Pediatric retinal photograph (wide-field):
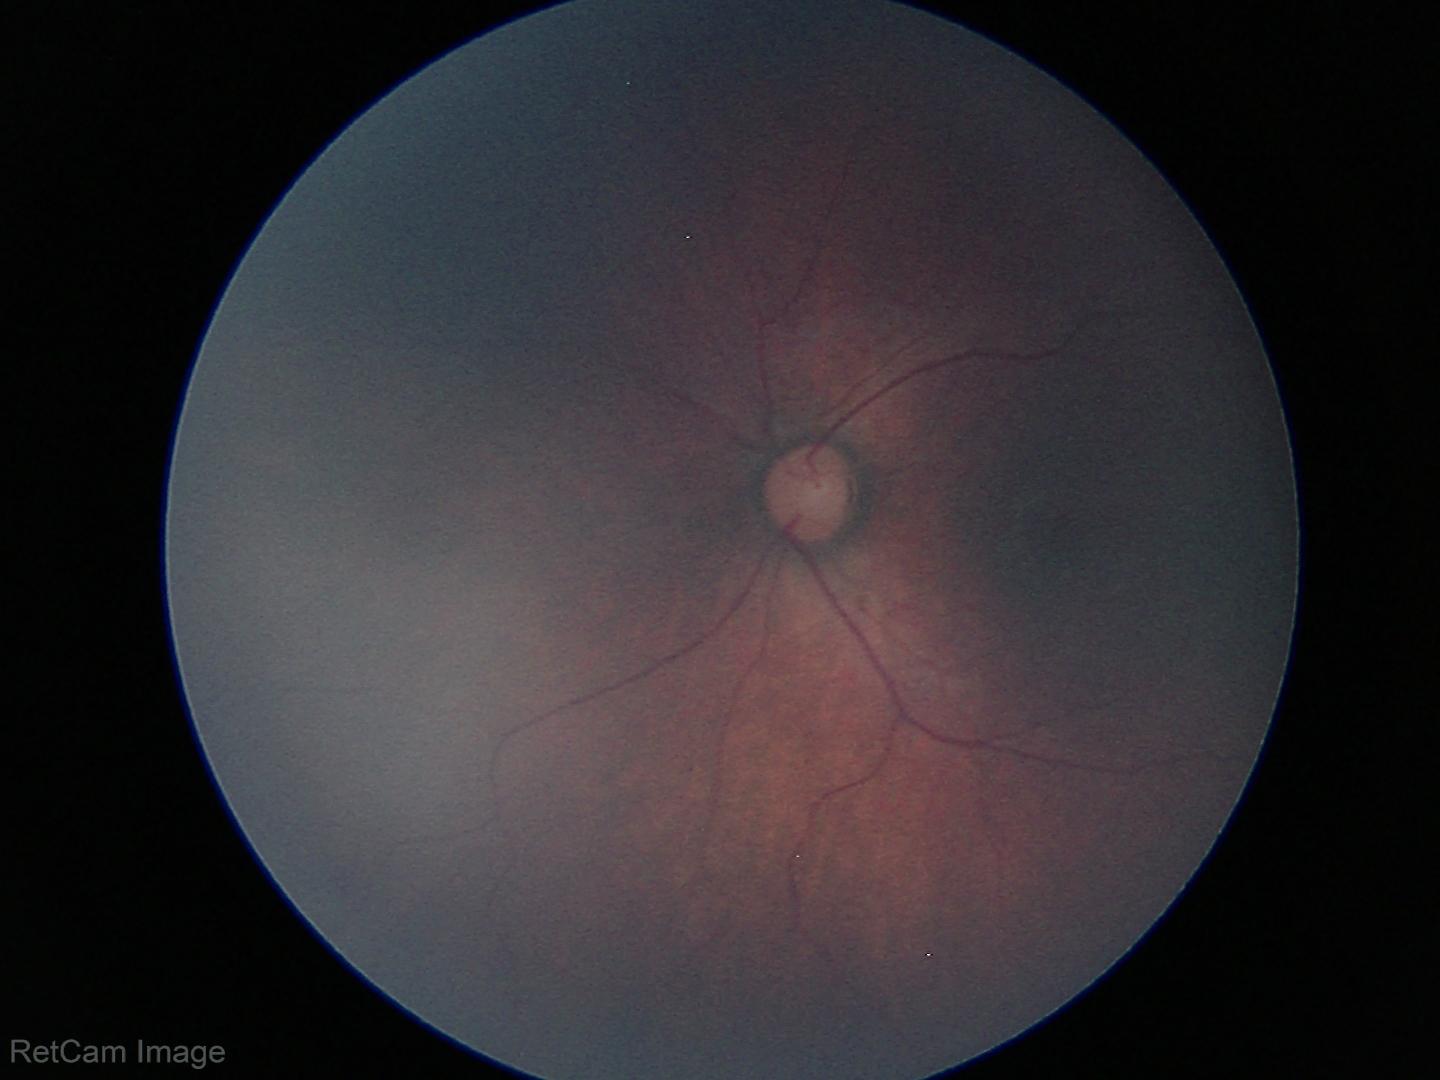 Normal screening examination.